240x240px — 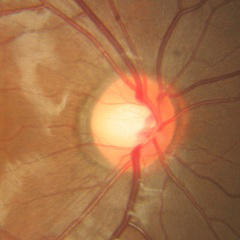
Q: Is glaucoma present?
A: No glaucoma.